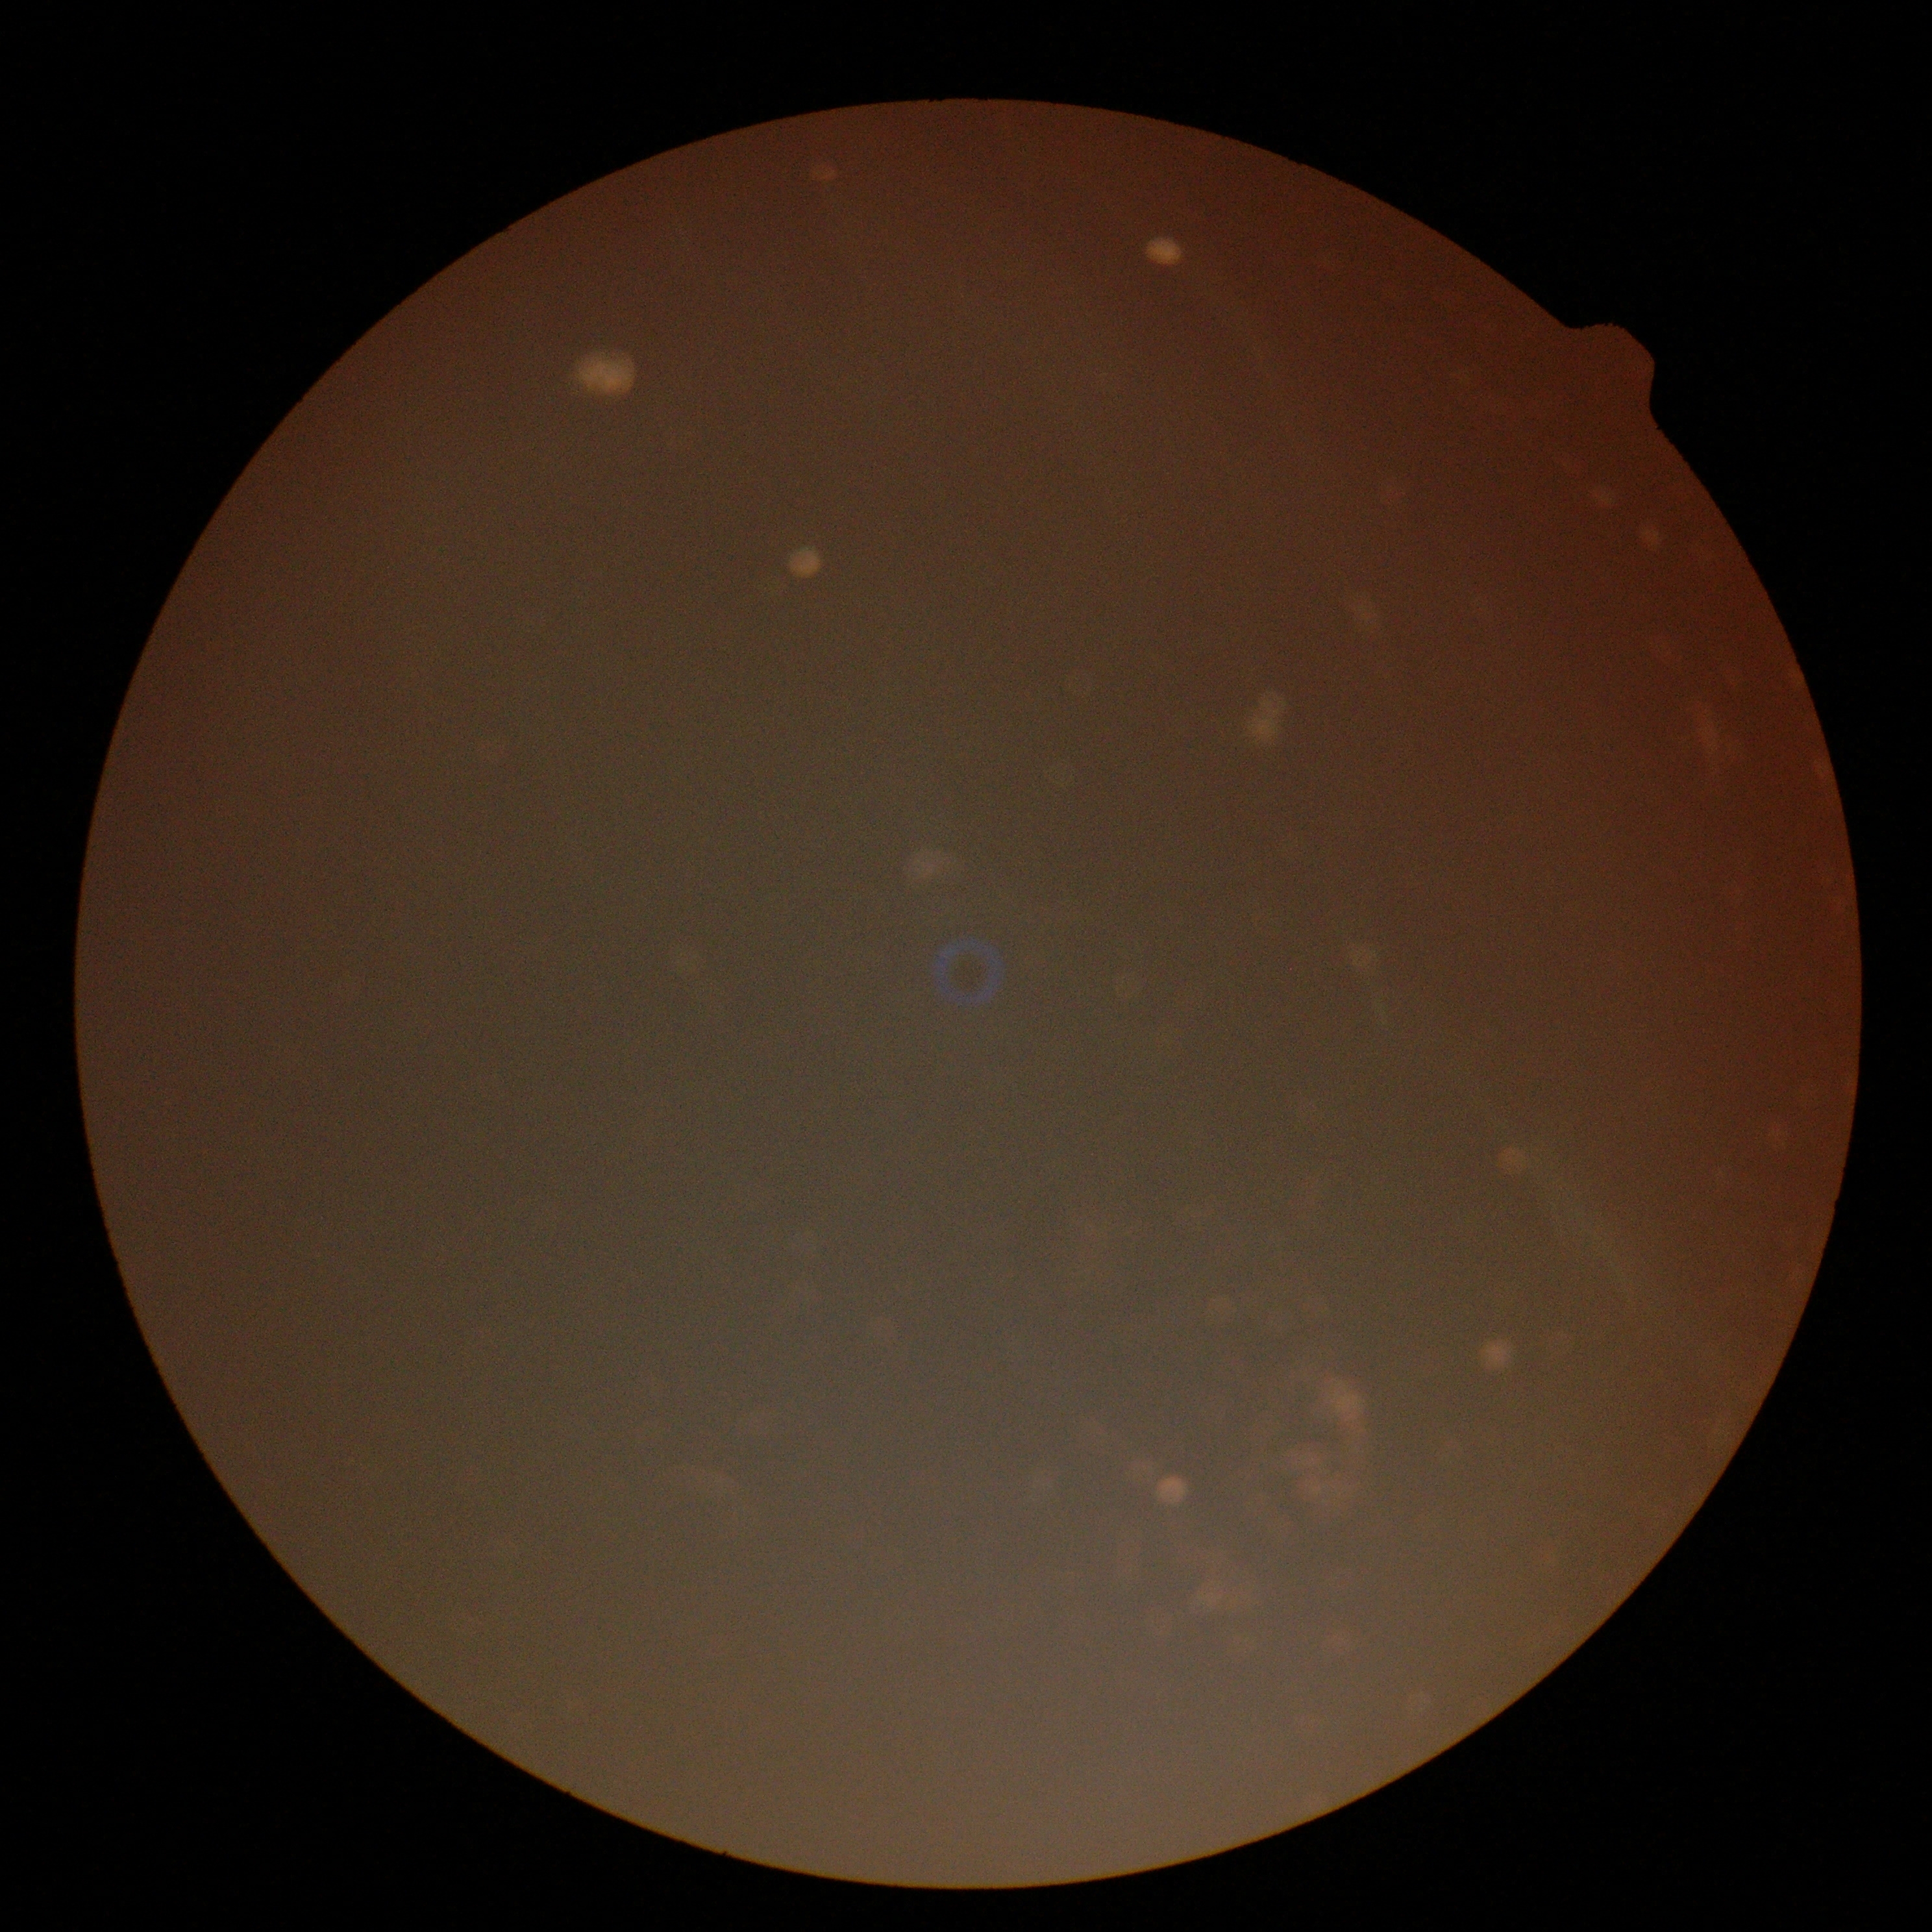
quality: insufficient for DR assessment
dr_grade: ungradable